1536x1152px:
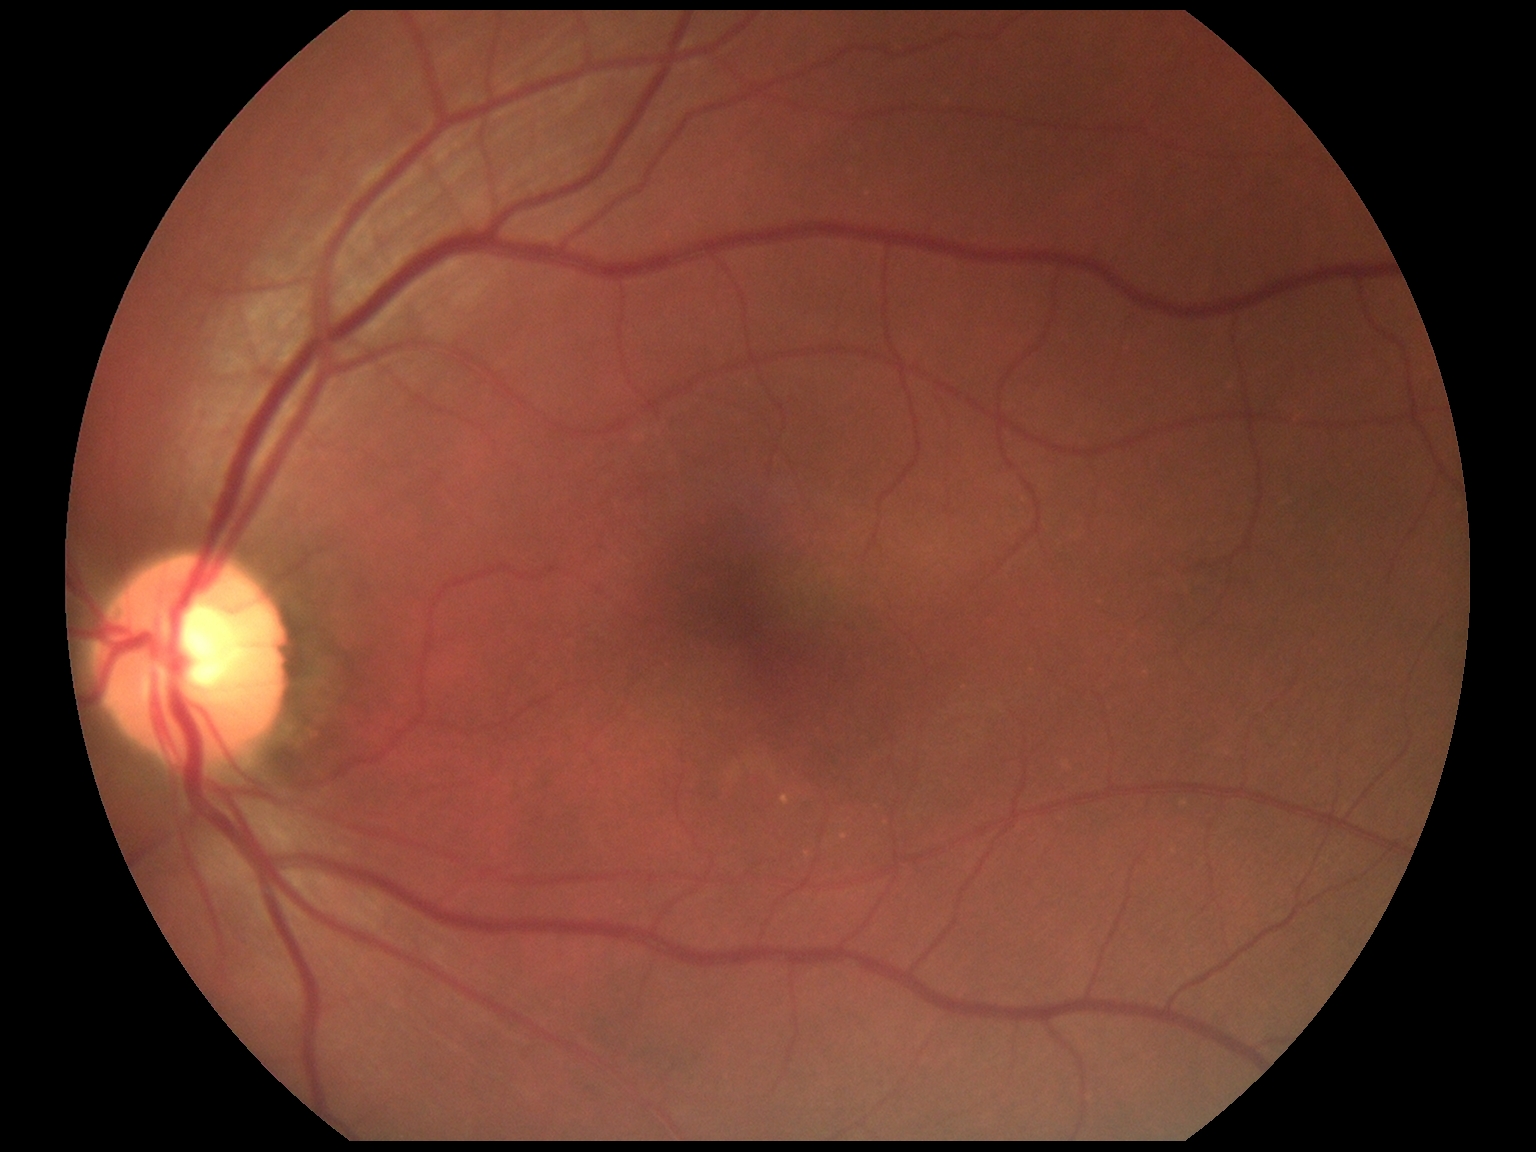

No DR findings. DR is no apparent retinopathy (grade 0).